2352 by 1568 pixels.
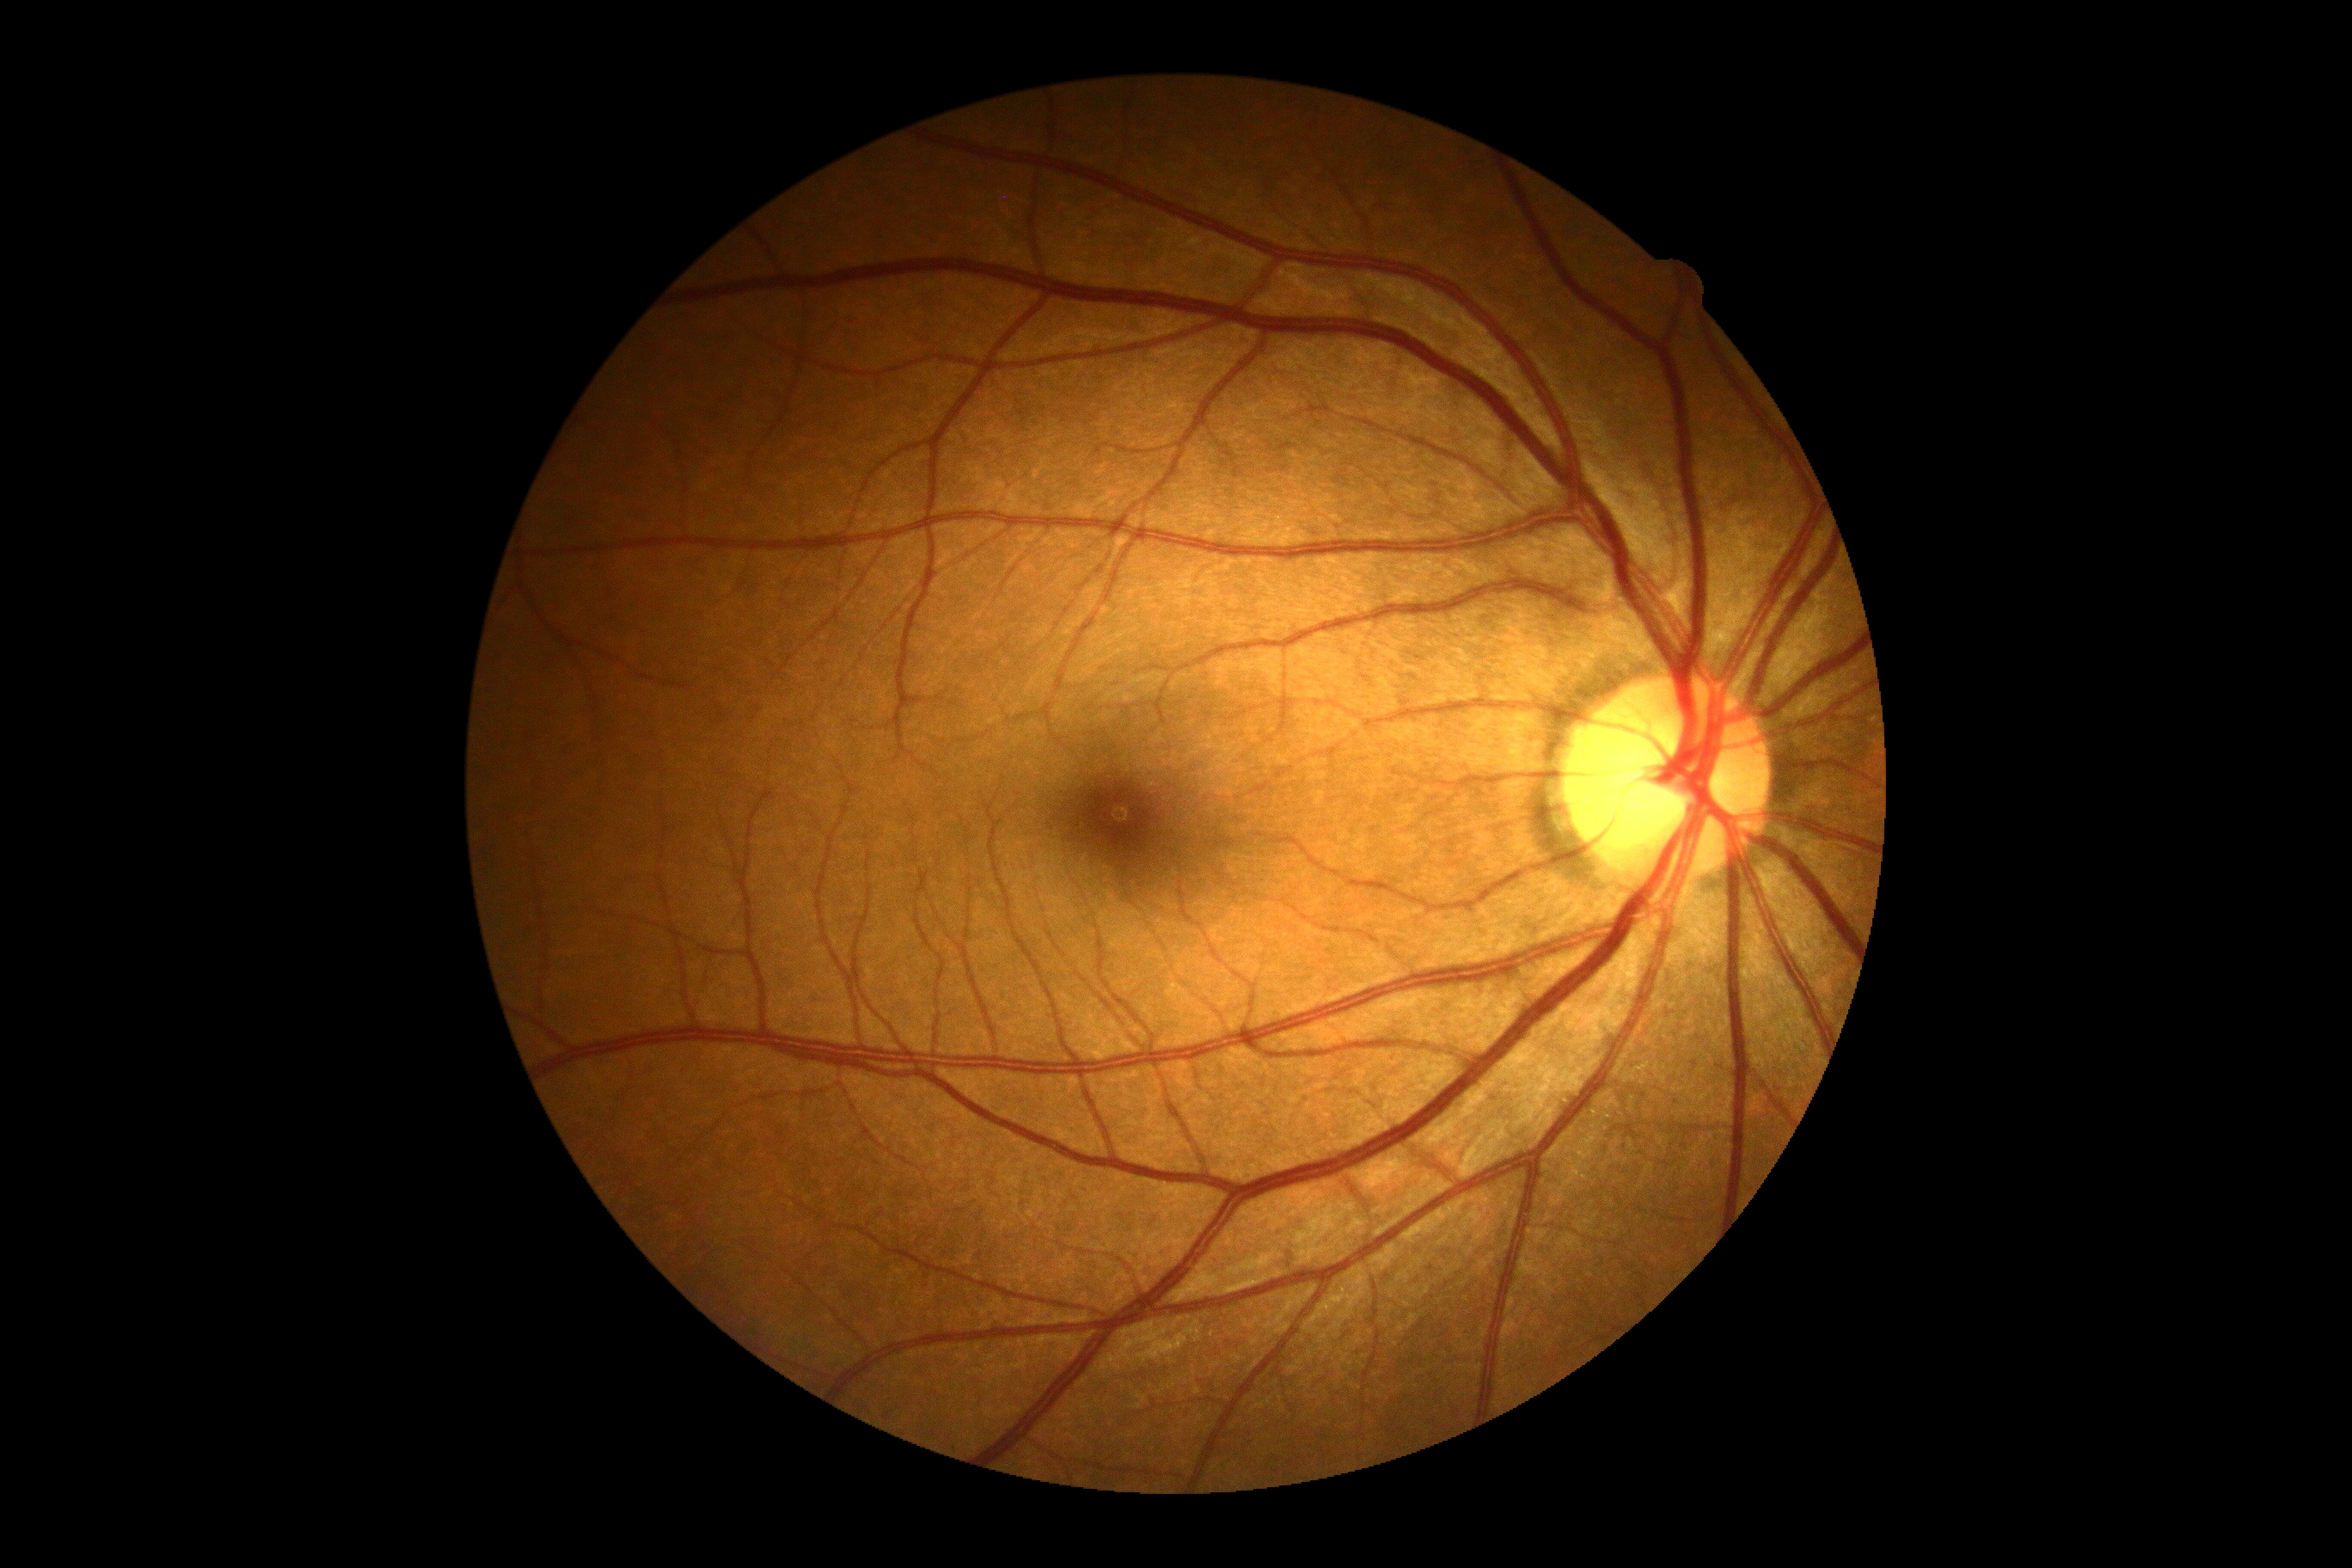

DR impression: no apparent DR; DR: 0/4.